45° FOV, color fundus image, nonmydriatic, DR severity per modified Davis staging — 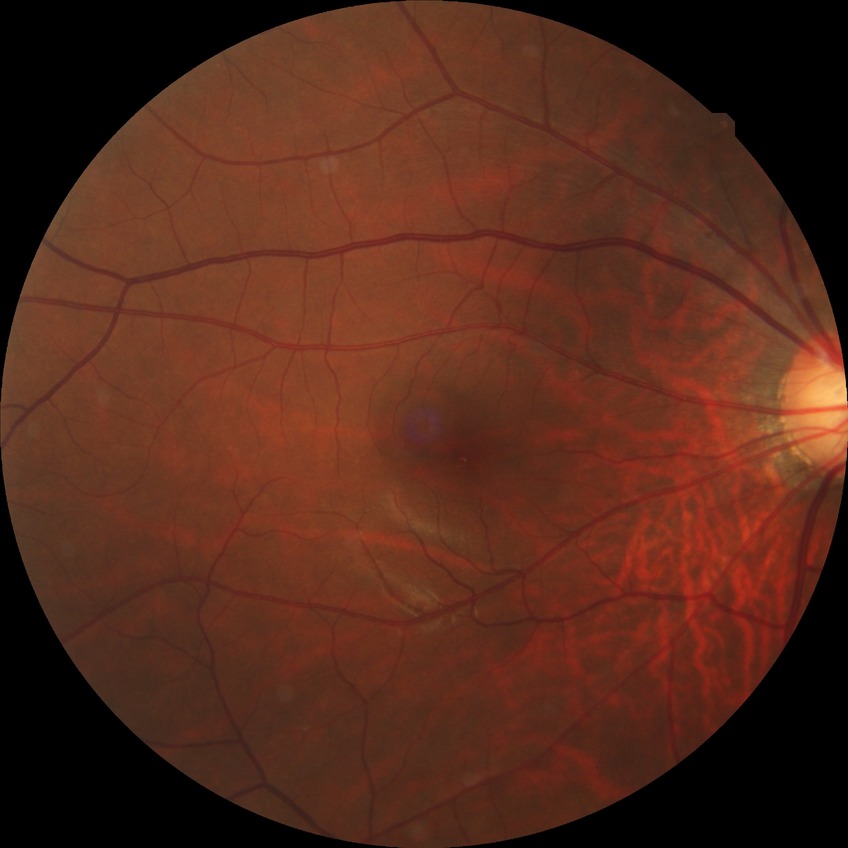
Diabetic retinopathy (DR): NDR (no diabetic retinopathy).